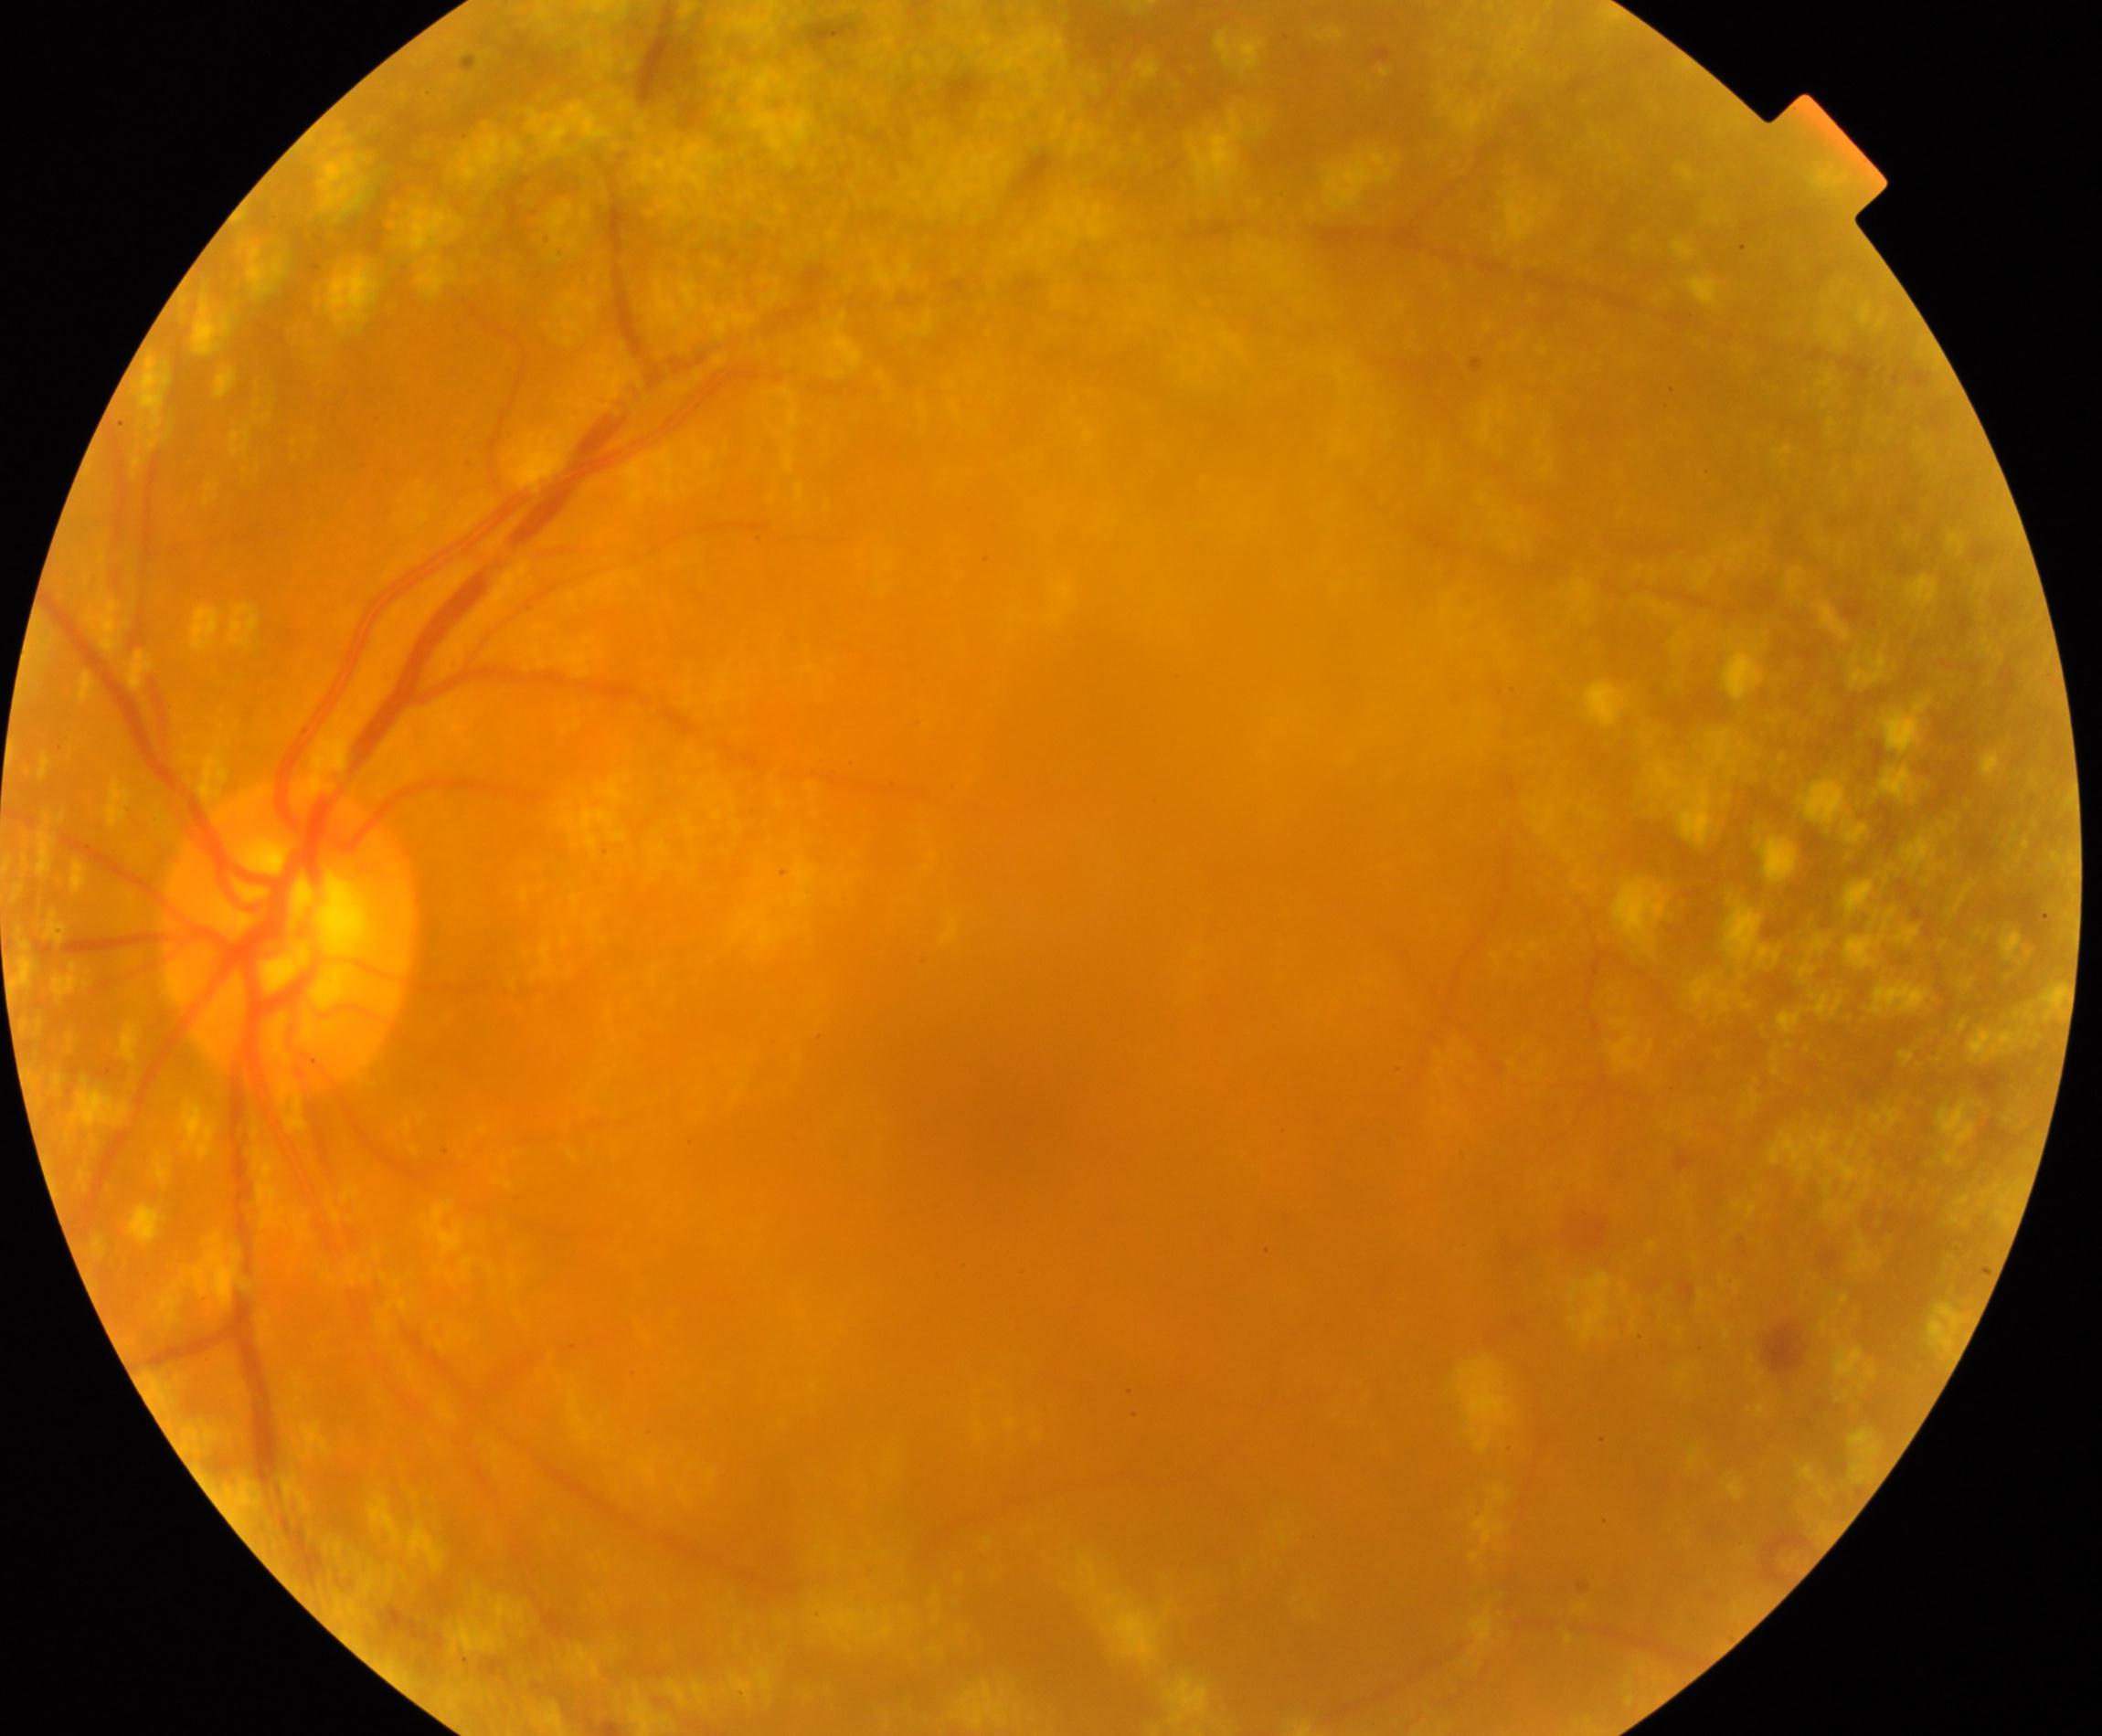
Demonstrates vitreous particles.